240 x 240 pixels:
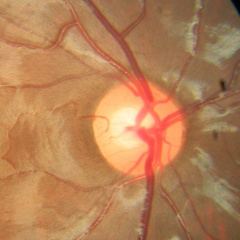 There is evidence of no glaucomatous optic neuropathy.